848 by 848 pixels · FOV: 45 degrees · NIDEK AFC-230 · without pupil dilation — 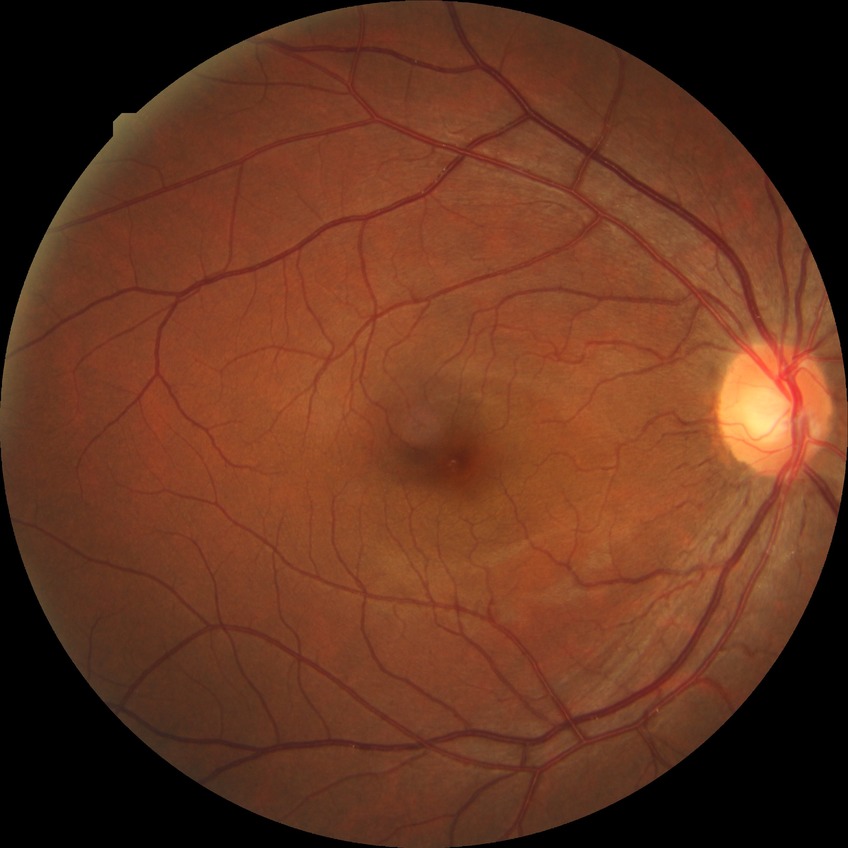 diabetic retinopathy (DR): NDR (no diabetic retinopathy).